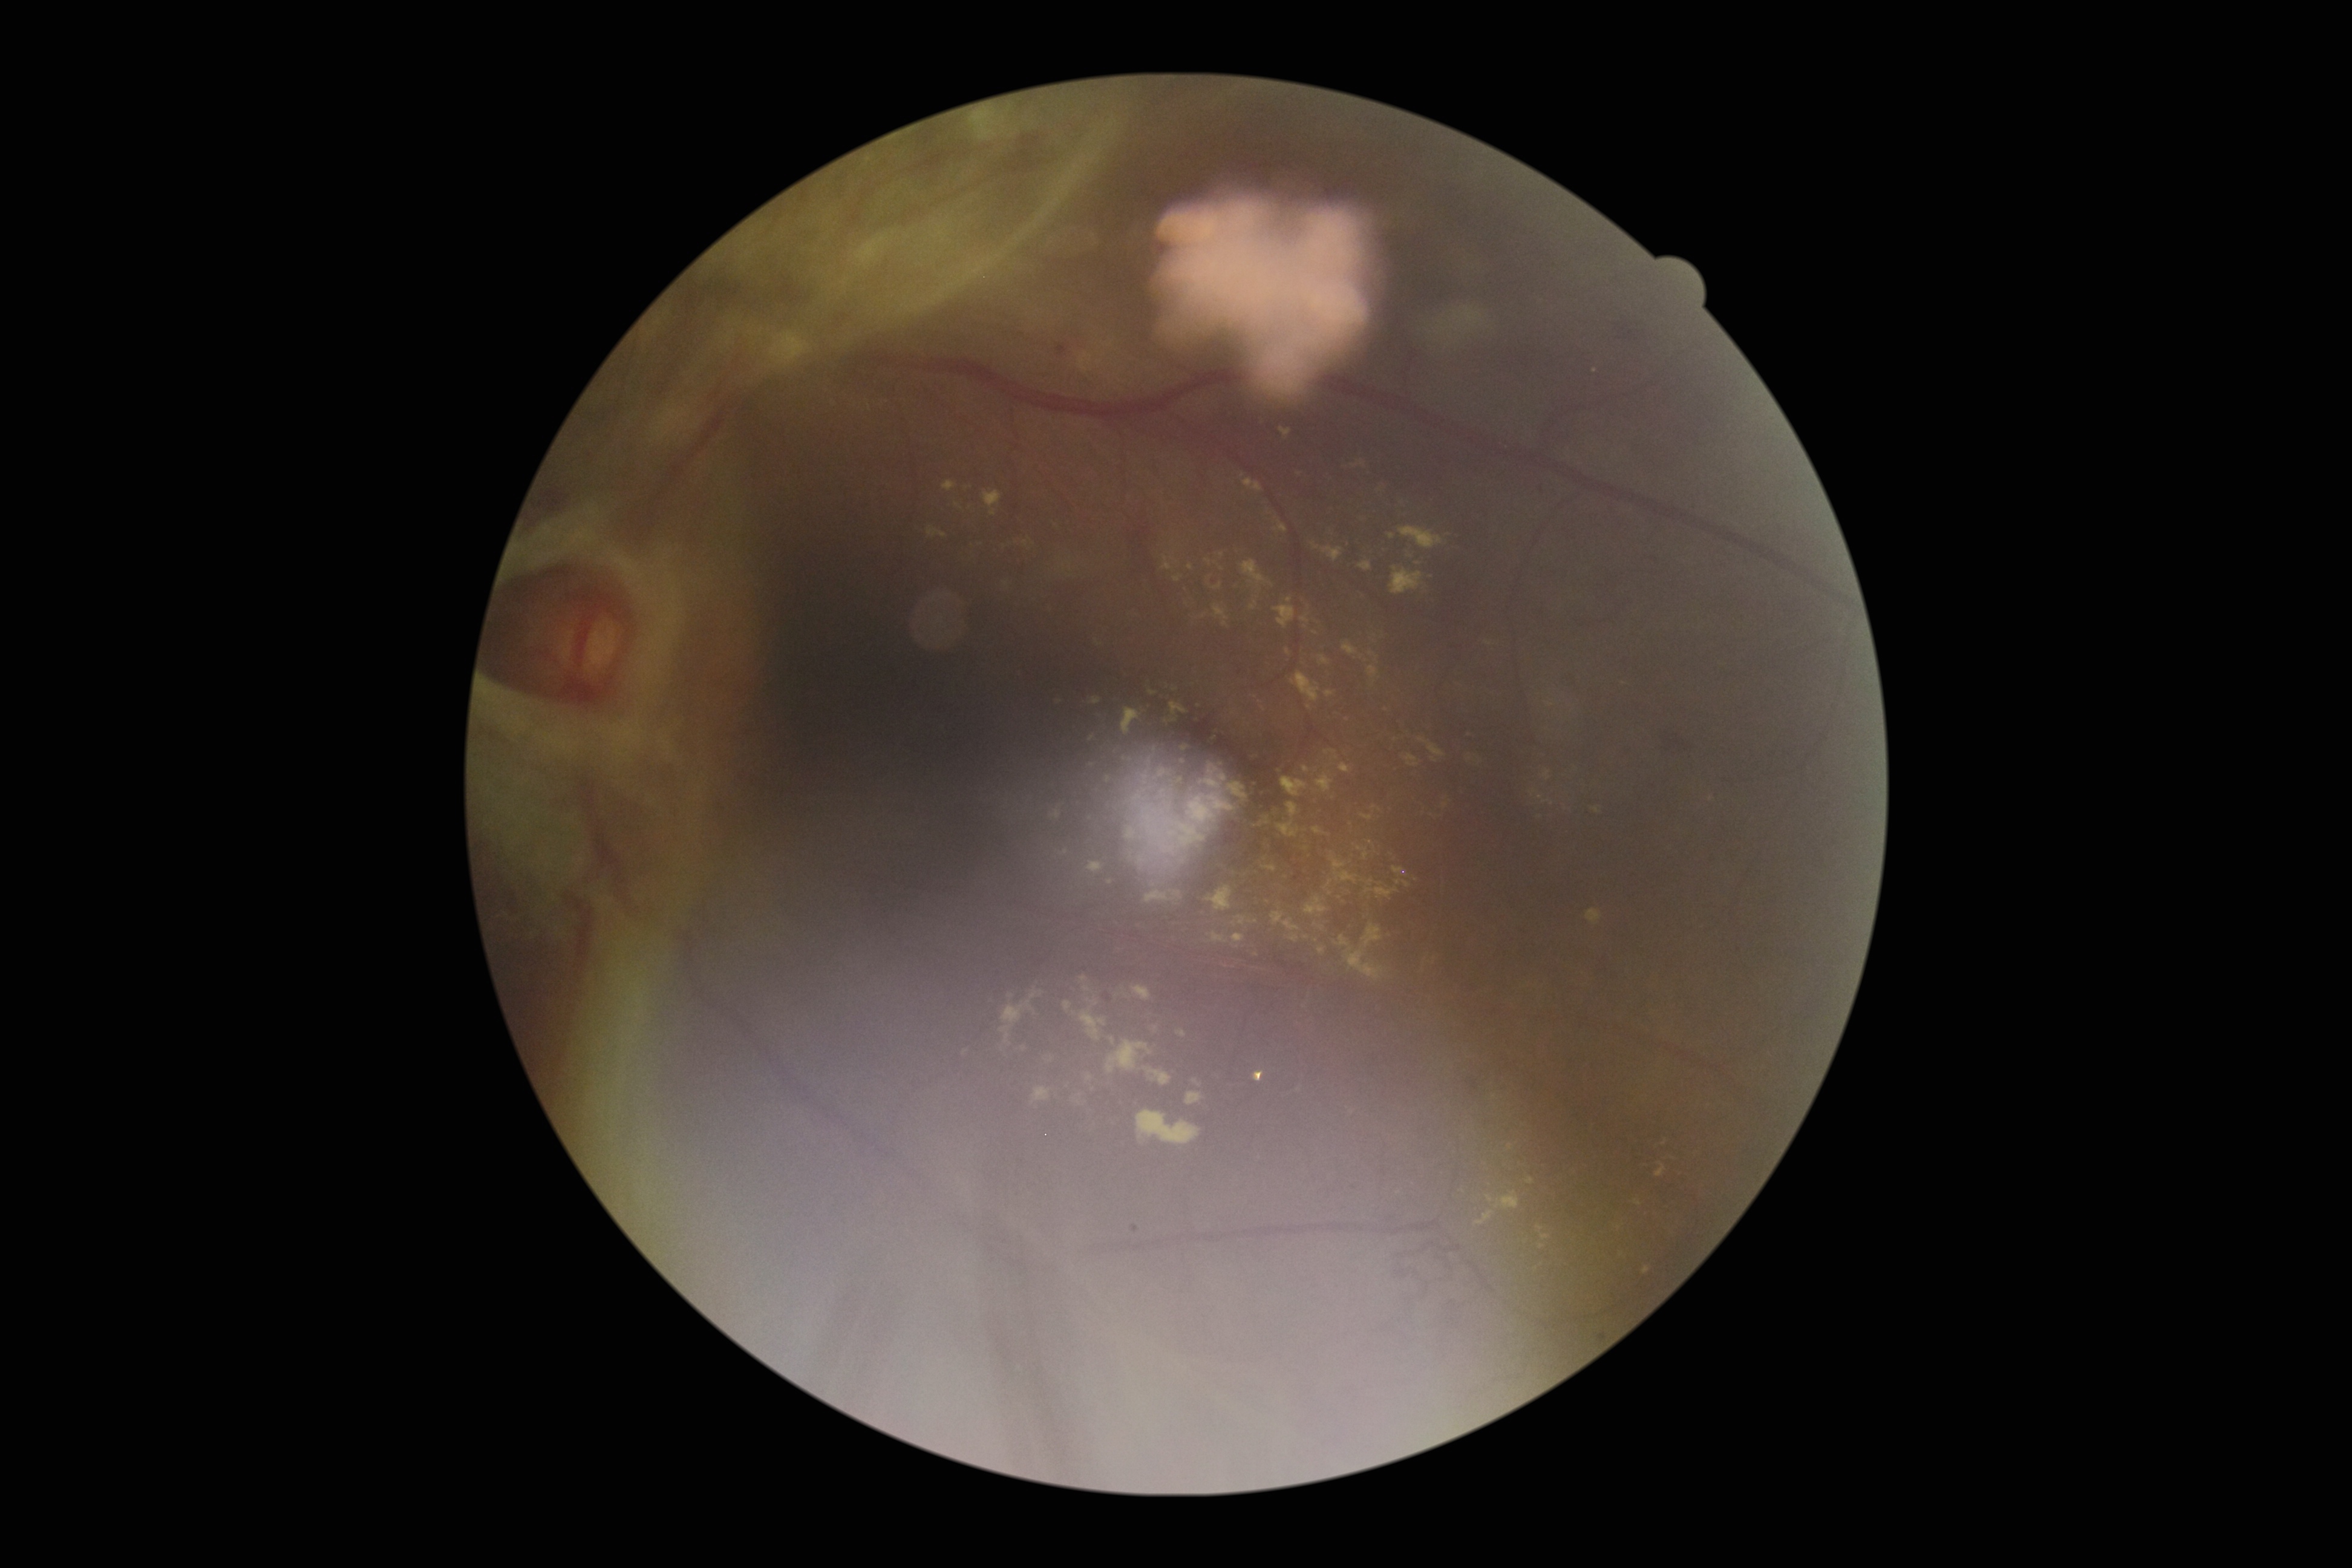
DR: PDR (grade 4).
EXs include lesions at BBox(1420, 949, 1433, 969); BBox(1056, 696, 1064, 702); BBox(1179, 1092, 1198, 1108); BBox(1058, 1000, 1074, 1011); BBox(1339, 923, 1392, 979); BBox(1388, 862, 1416, 885); BBox(1370, 666, 1380, 675); BBox(1140, 742, 1160, 760); BBox(1208, 733, 1215, 747); BBox(943, 481, 956, 492); BBox(1369, 653, 1380, 664); BBox(1083, 1079, 1097, 1094); BBox(1223, 869, 1260, 880); BBox(1129, 983, 1151, 1007); BBox(1399, 527, 1443, 549).
Smaller EXs around <point>1543, 1248</point>; <point>1530, 1181</point>; <point>1092, 740</point>.